2352 x 1568 pixels; color fundus photograph.
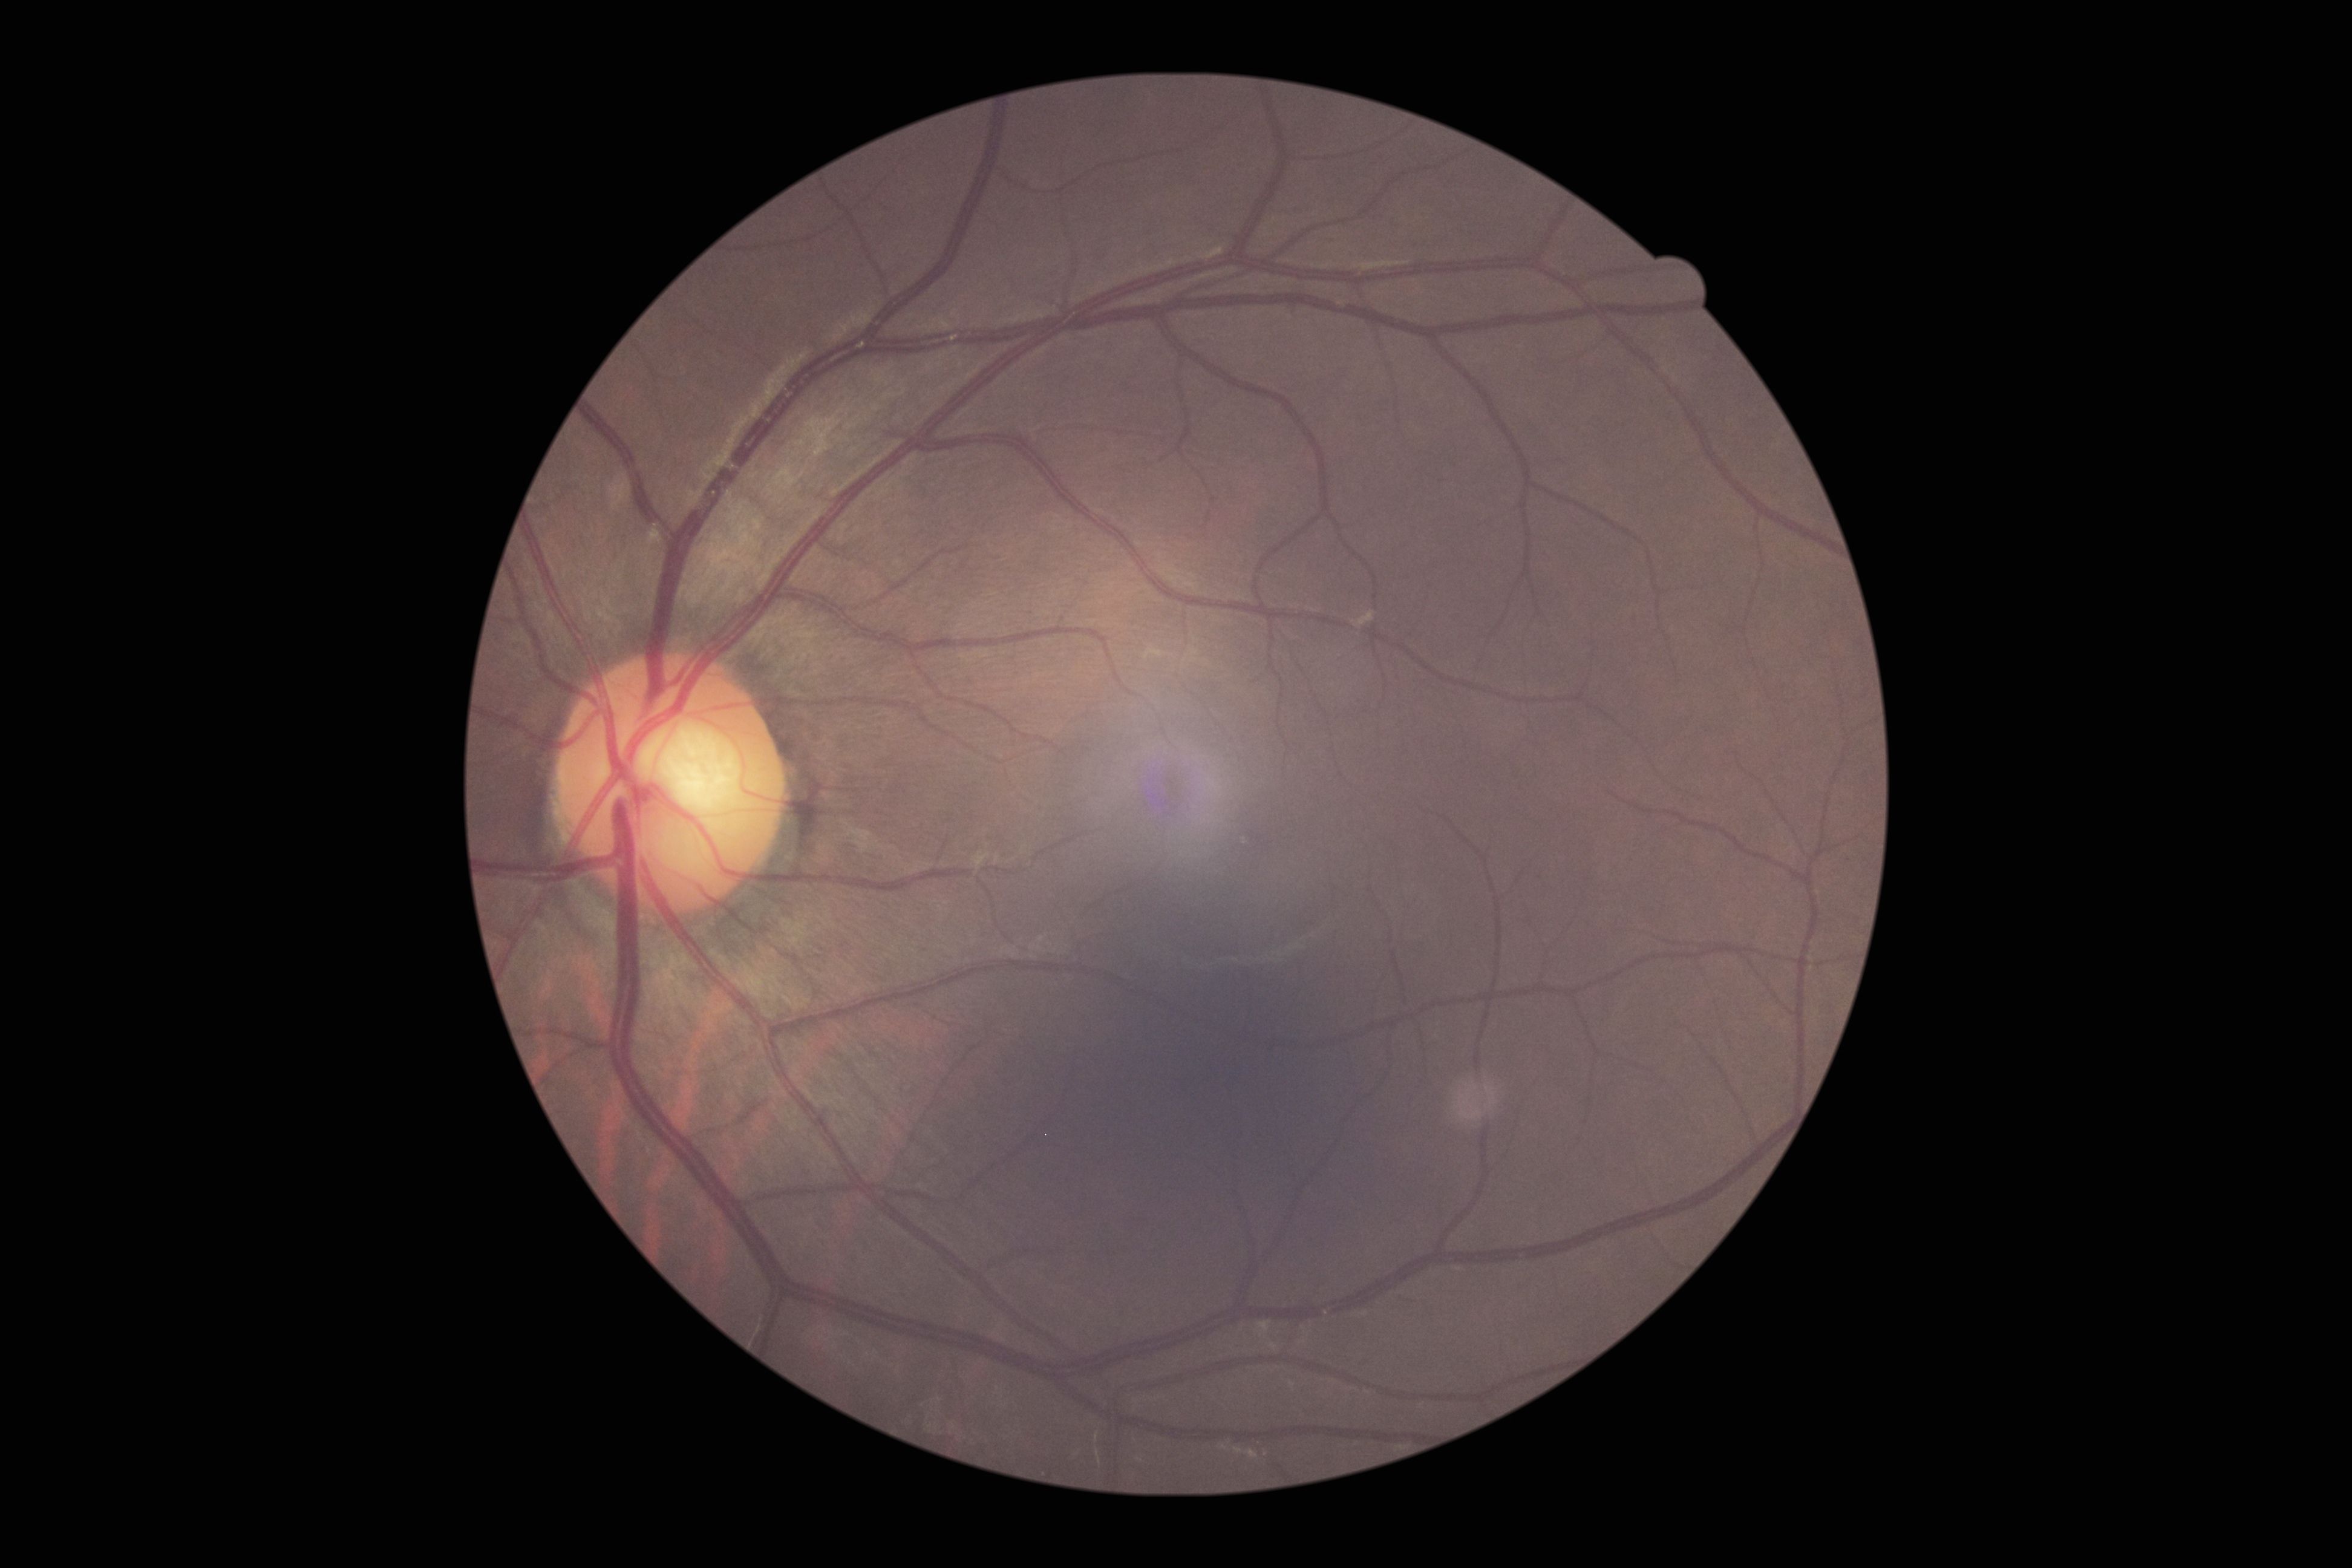
diabetic retinopathy severity = grade 0.